FOV: 45 degrees: 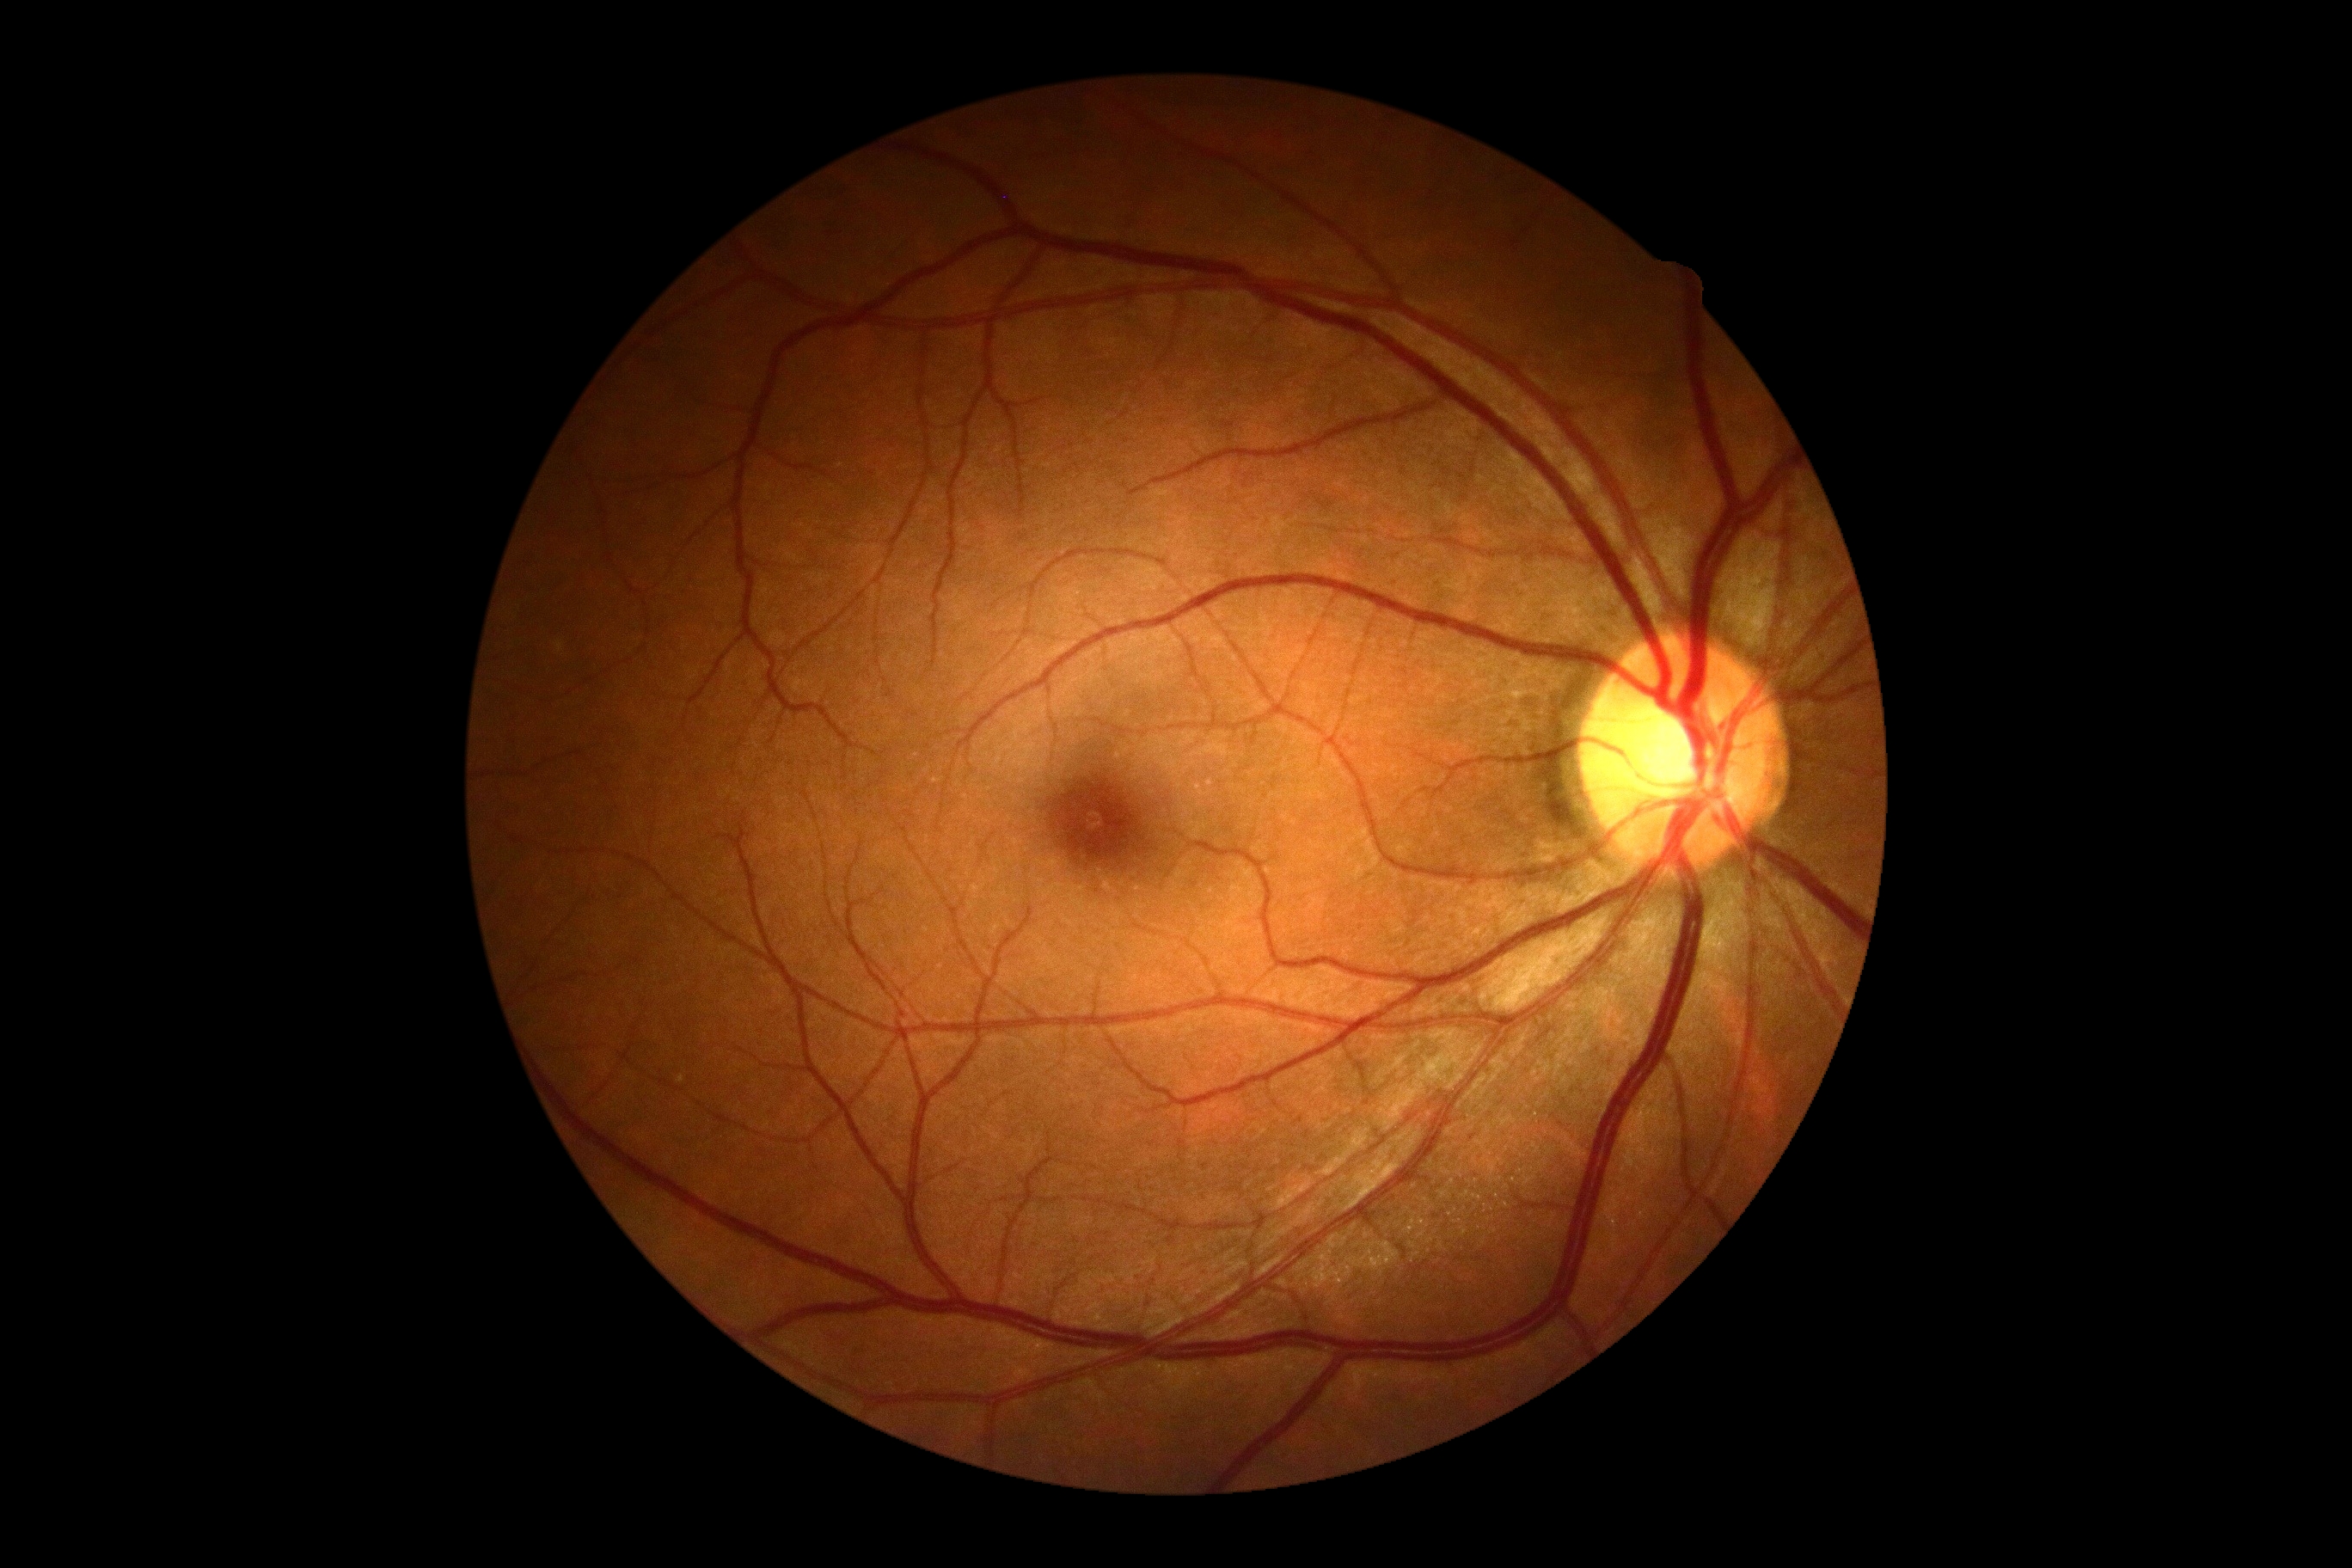 Diabetic retinopathy (DR): 0.